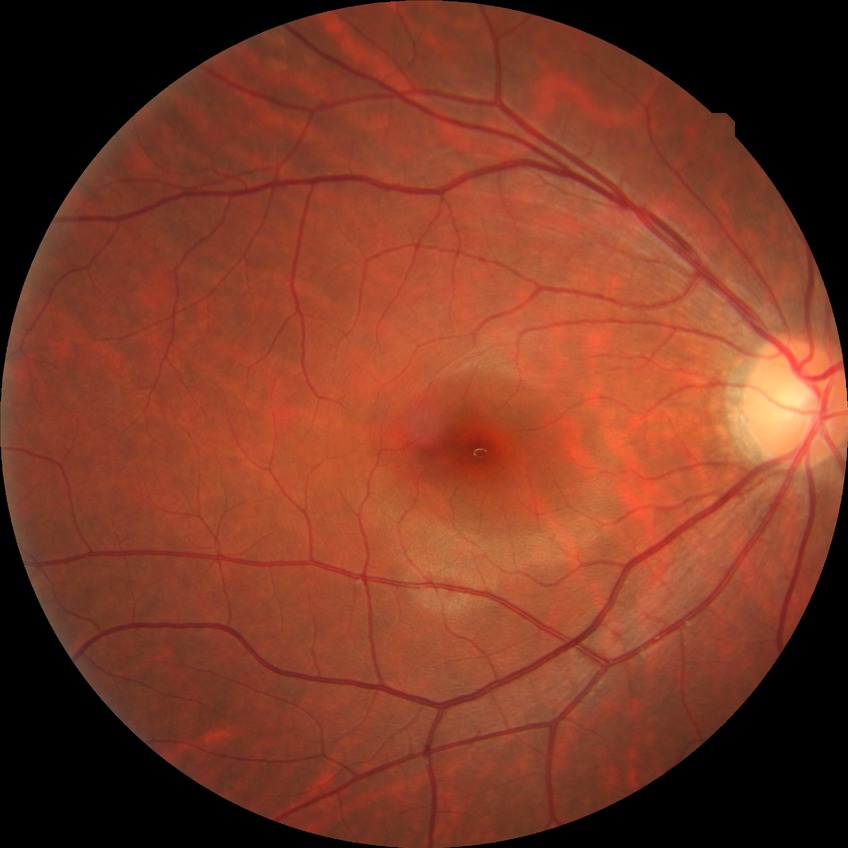
Diabetic retinopathy (DR) is NDR (no diabetic retinopathy).